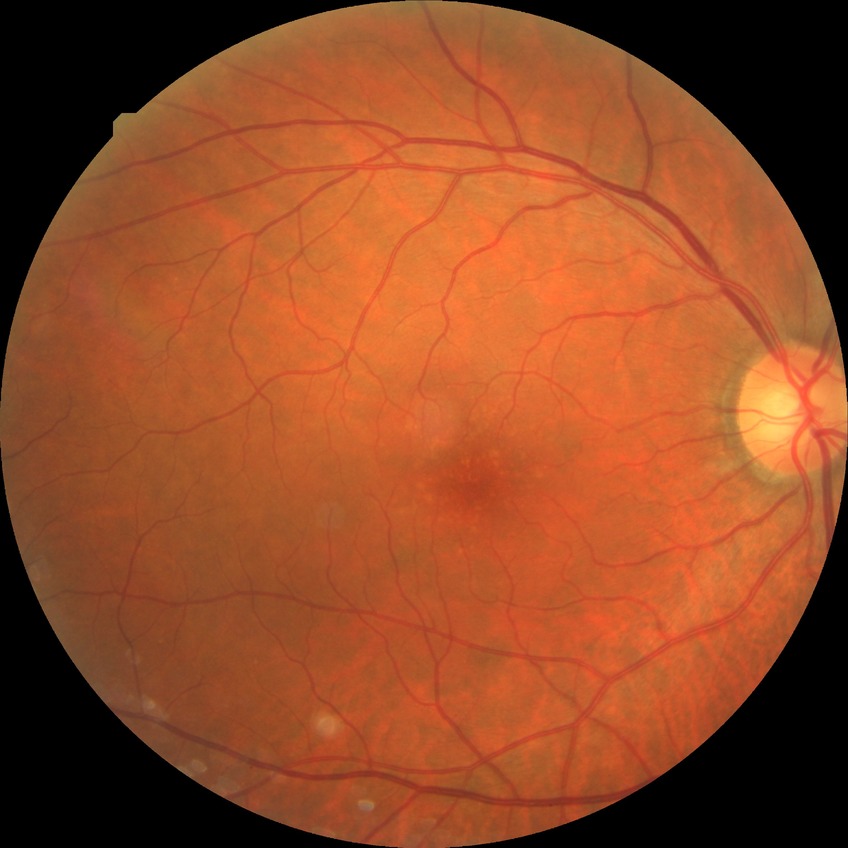 Diabetic retinopathy (DR) is no diabetic retinopathy (NDR).